1924 x 1556 pixels, ultra-widefield (UWF) fundus image.
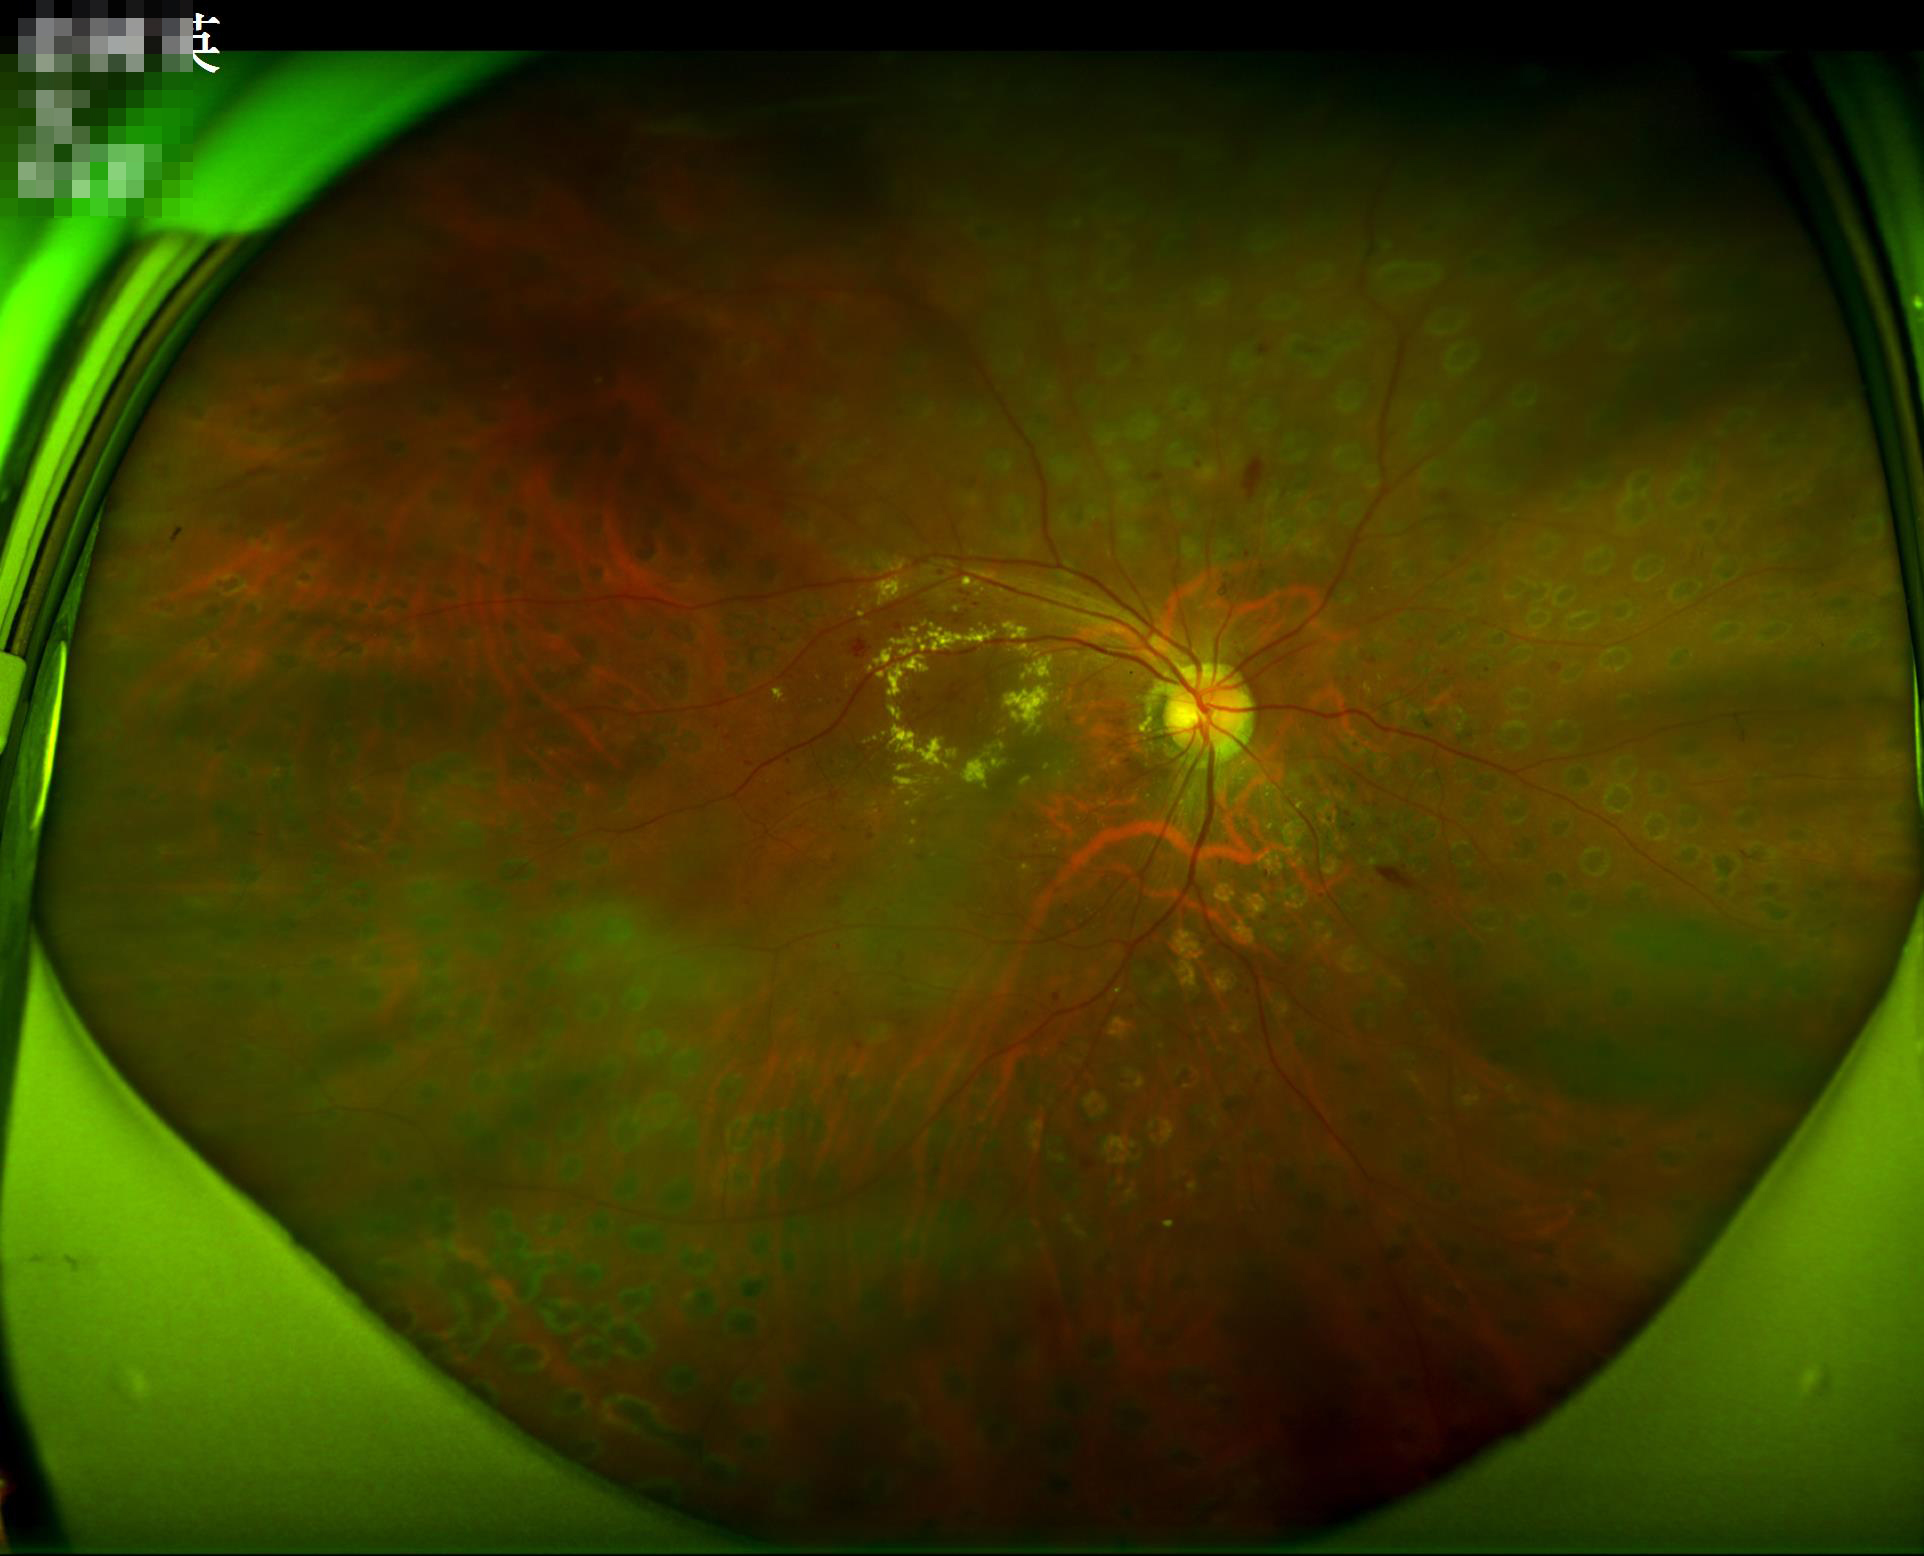 Overall quality = adequate for clinical interpretation
Illumination = over- or under-exposed